FOV: 45 degrees.
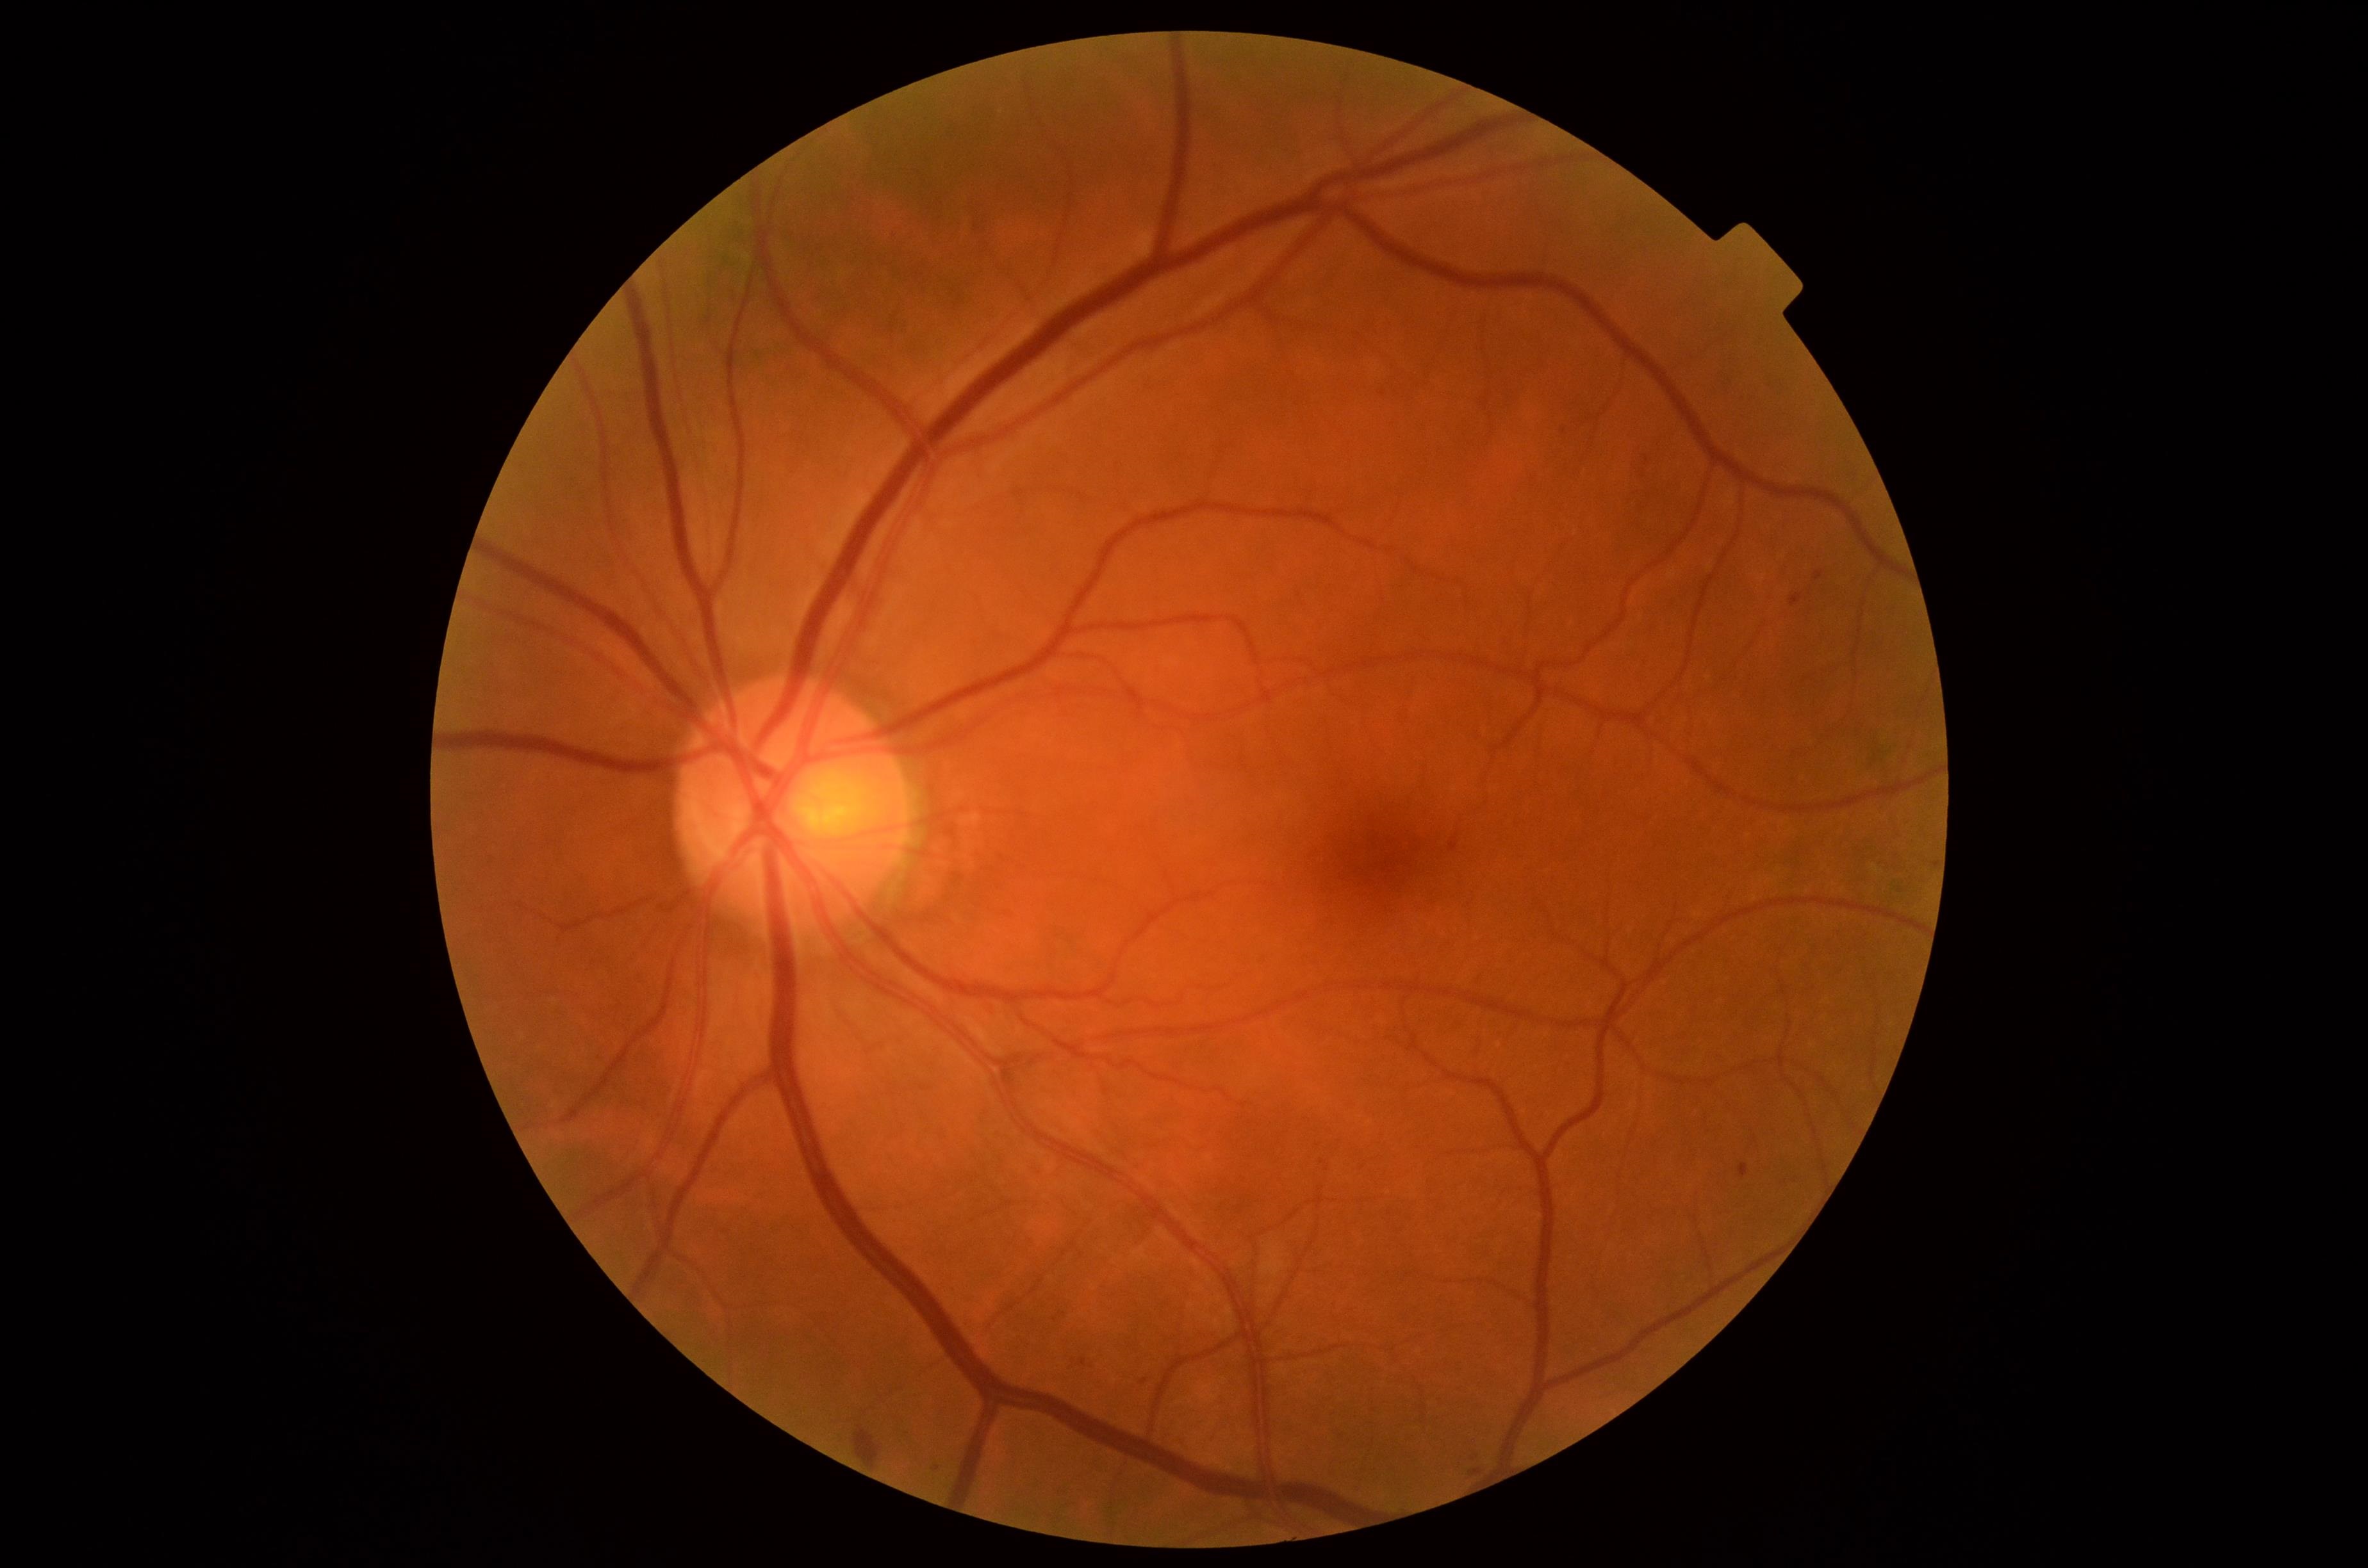
{"dr_grade": "grade 2", "dr_category": "non-proliferative diabetic retinopathy"}